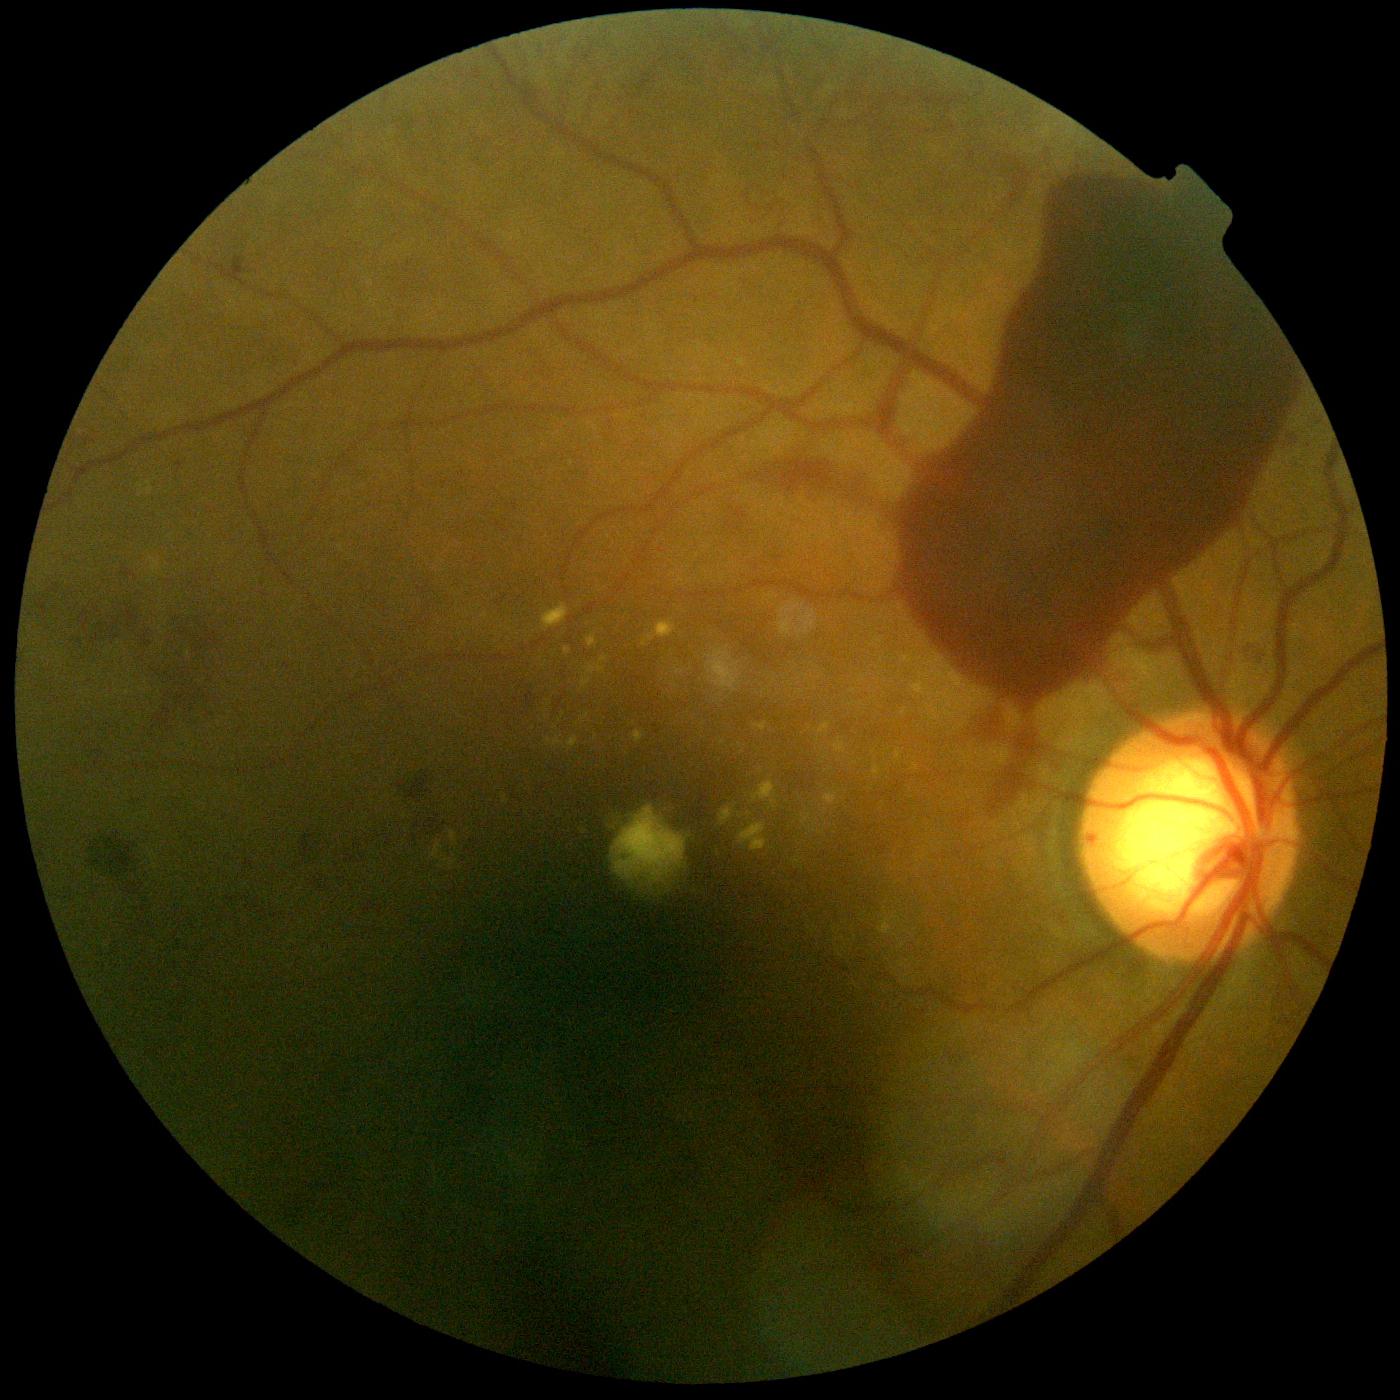
dr_grade: 4 (PDR) — neovascularization and/or vitreous/pre-retinal hemorrhage